1440 x 1080 pixels · wide-field contact fundus photograph of an infant: 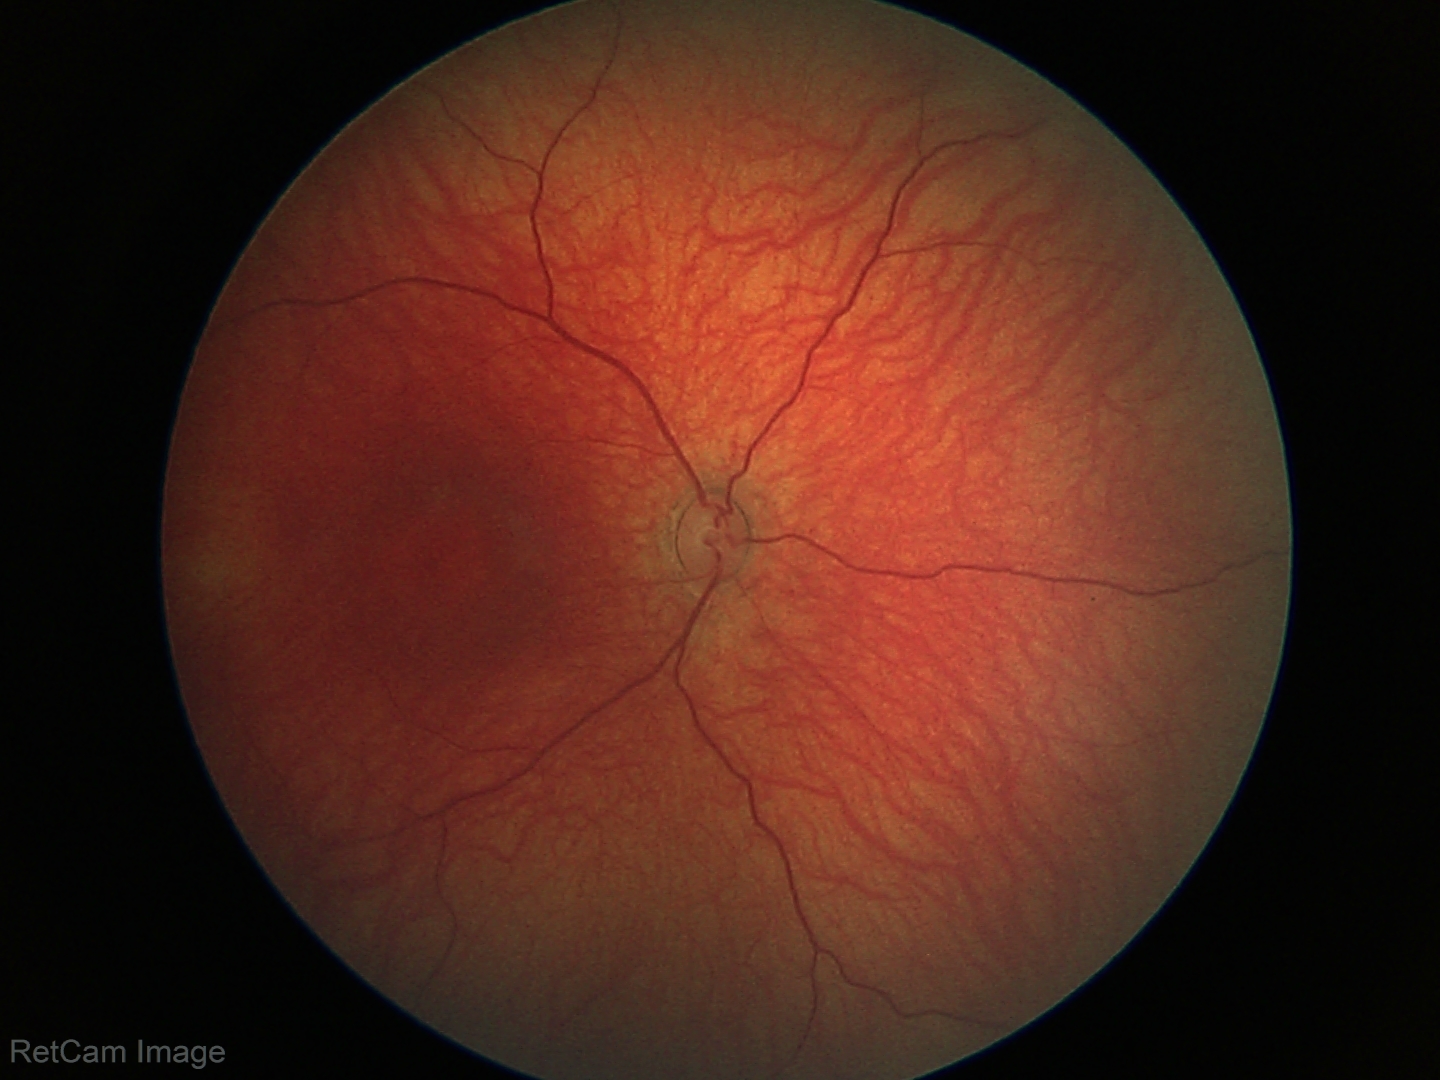

Diagnosis = physiological.